45° field of view; retinal fundus photograph; NIDEK AFC-230 fundus camera
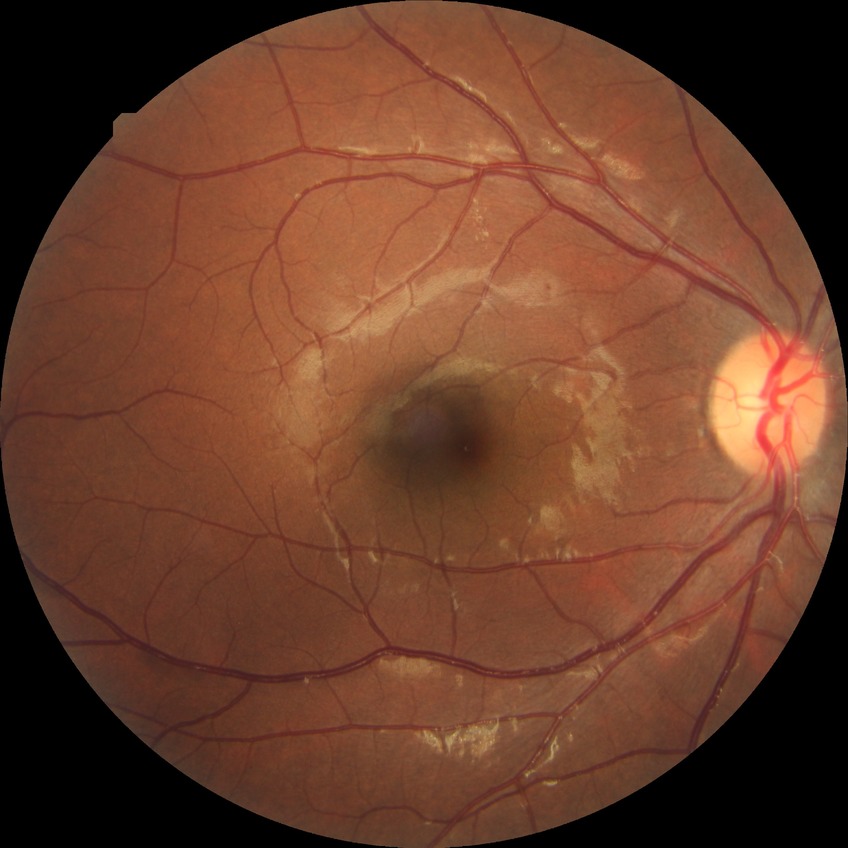
{
  "davis_grade": "simple diabetic retinopathy (SDR)"
}